Optic disc region of a color fundus photo, 35° FOV before cropping.
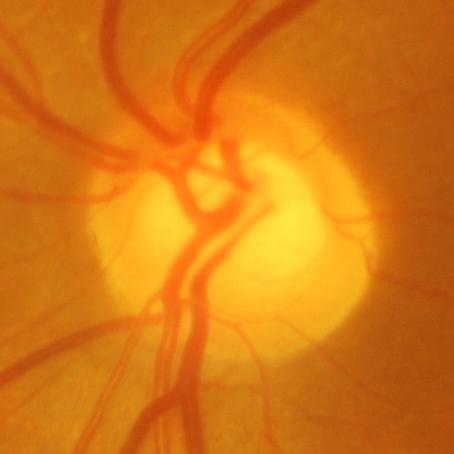

Glaucomatous optic neuropathy is present. The image shows glaucomatous findings.